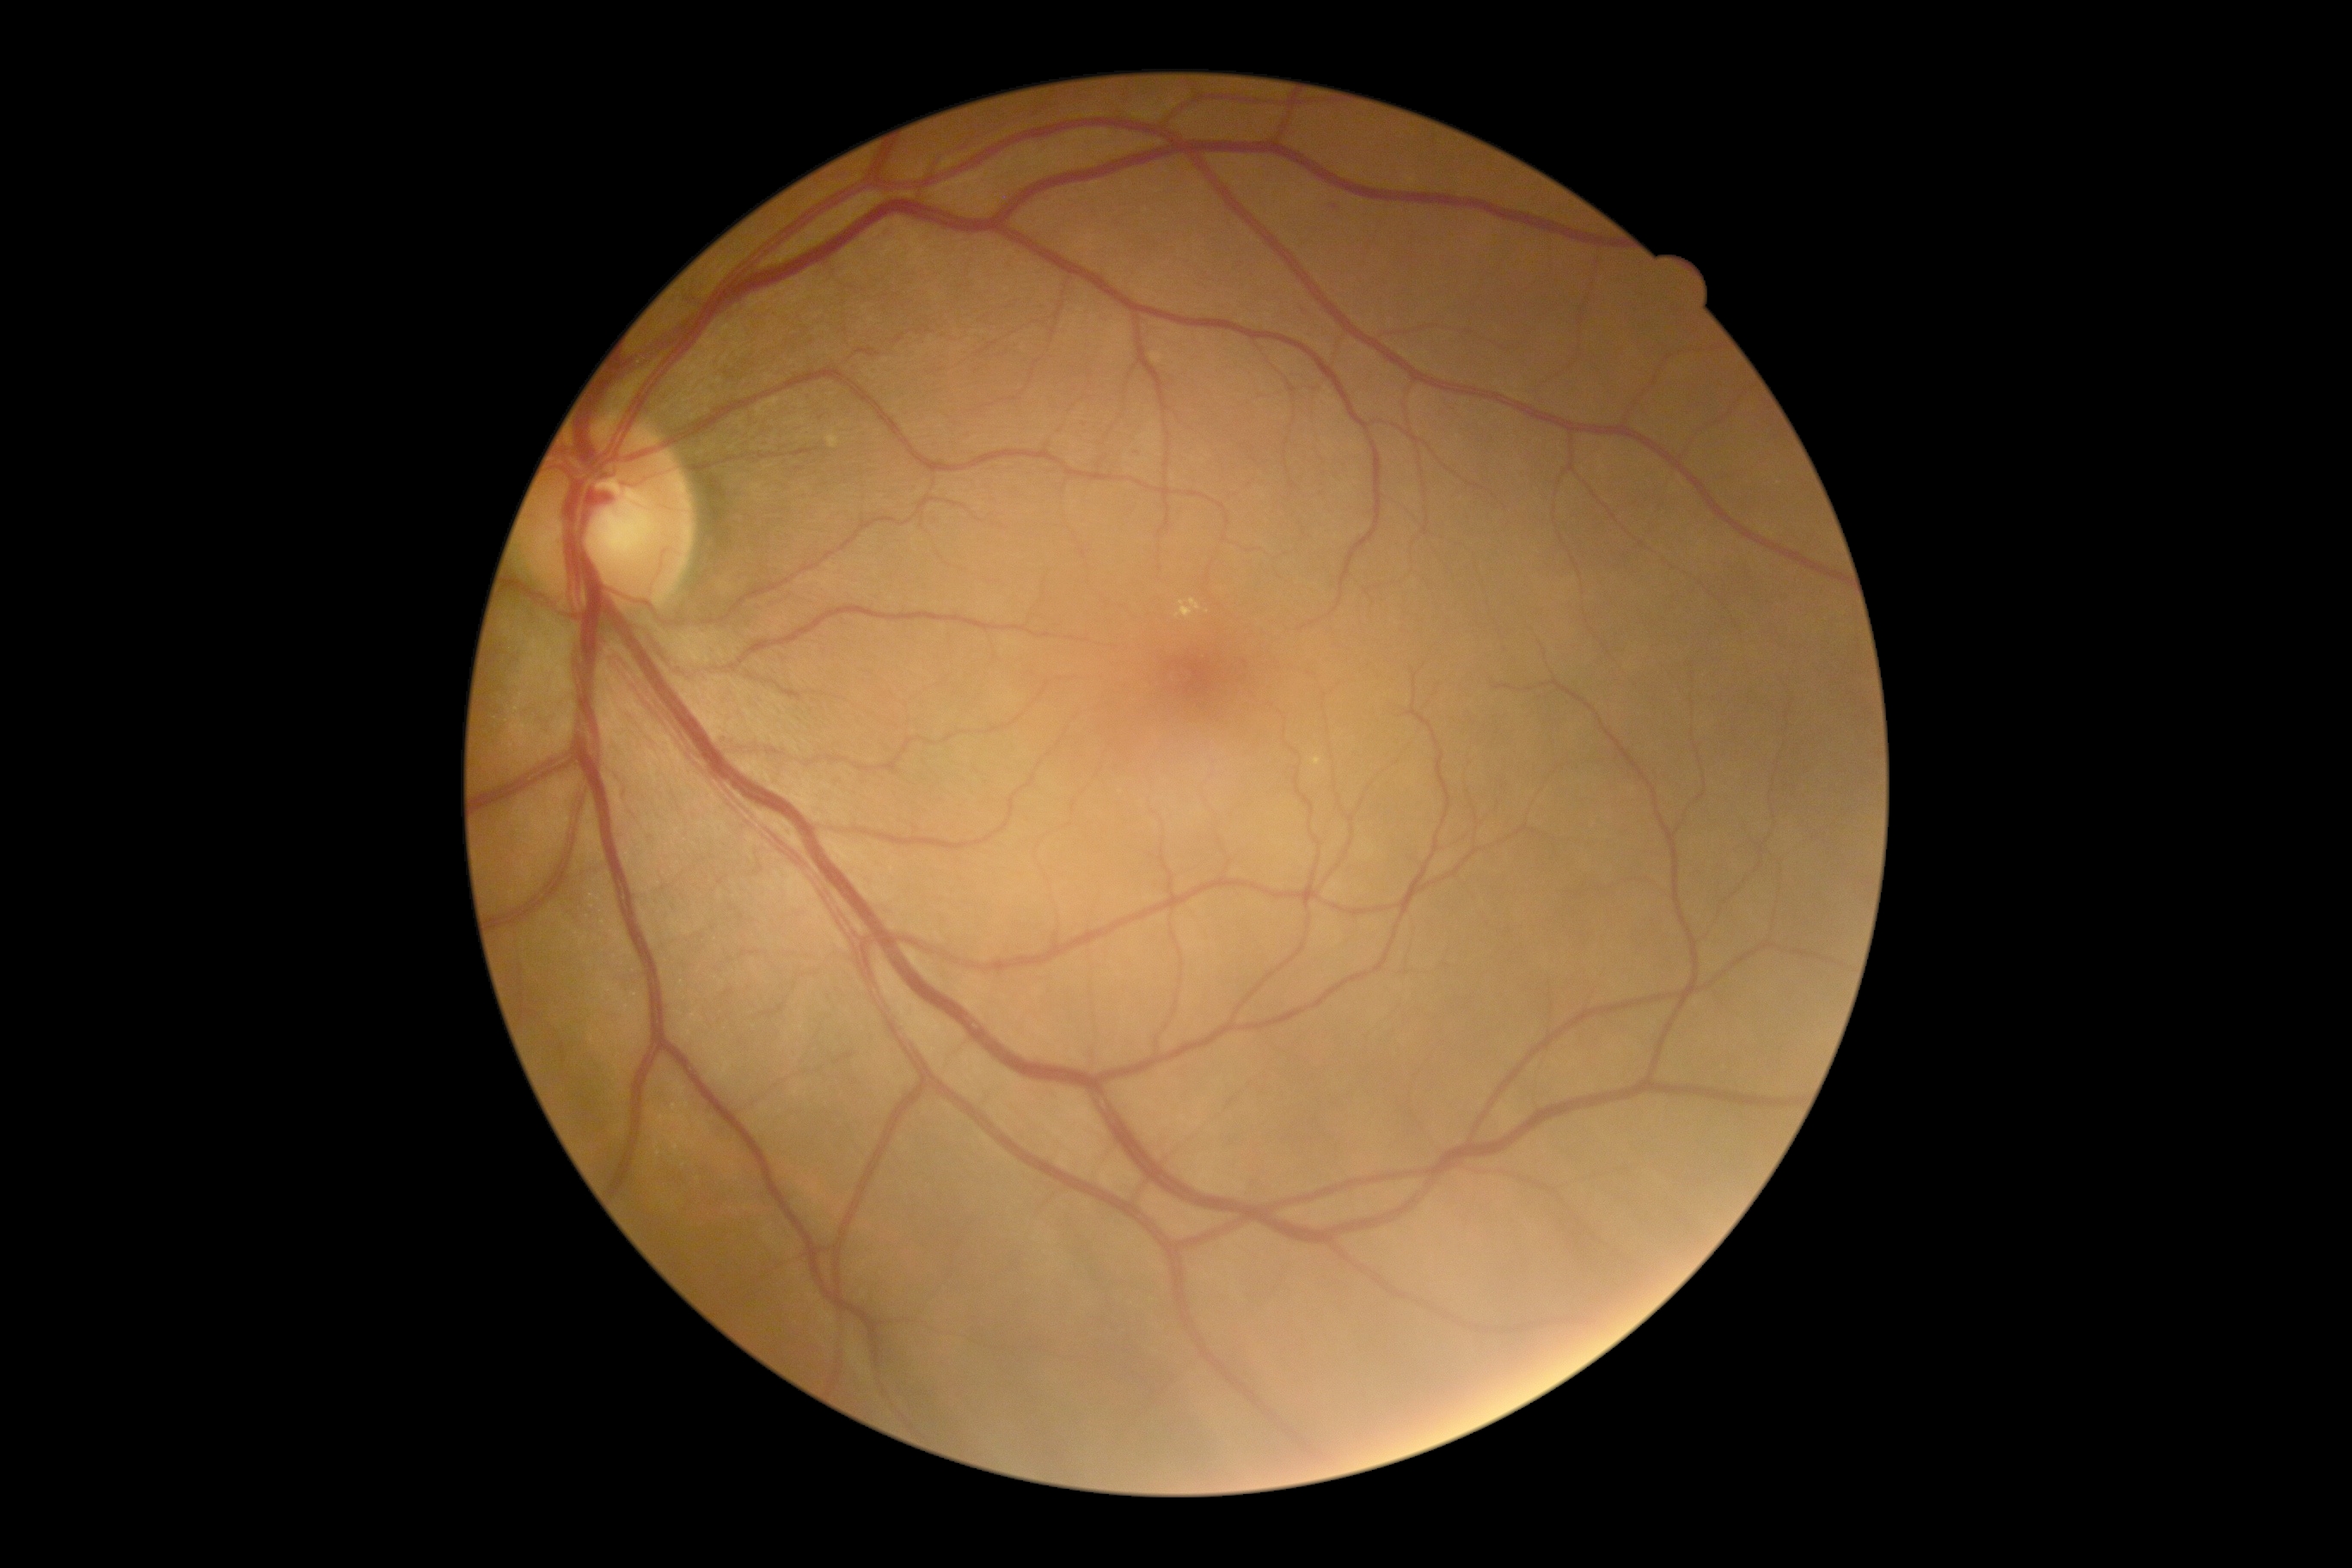

Retinopathy is moderate non-proliferative diabetic retinopathy (grade 2). The retinopathy is classified as non-proliferative diabetic retinopathy.